848 by 848 pixels · 45-degree field of view.
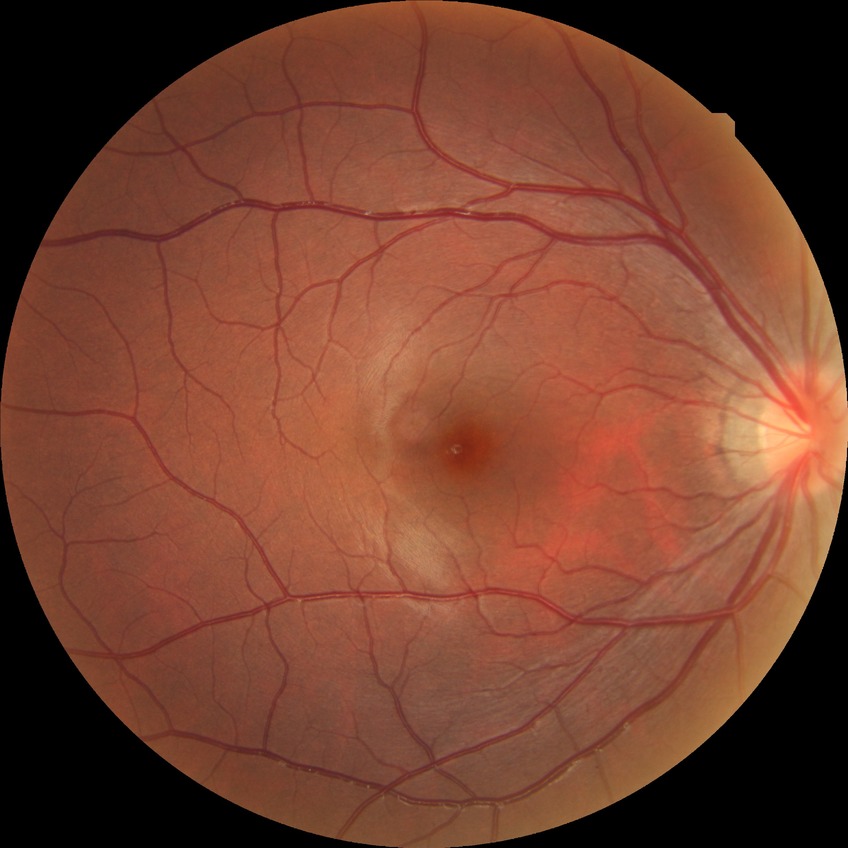
Diabetic retinopathy stage: no diabetic retinopathy.